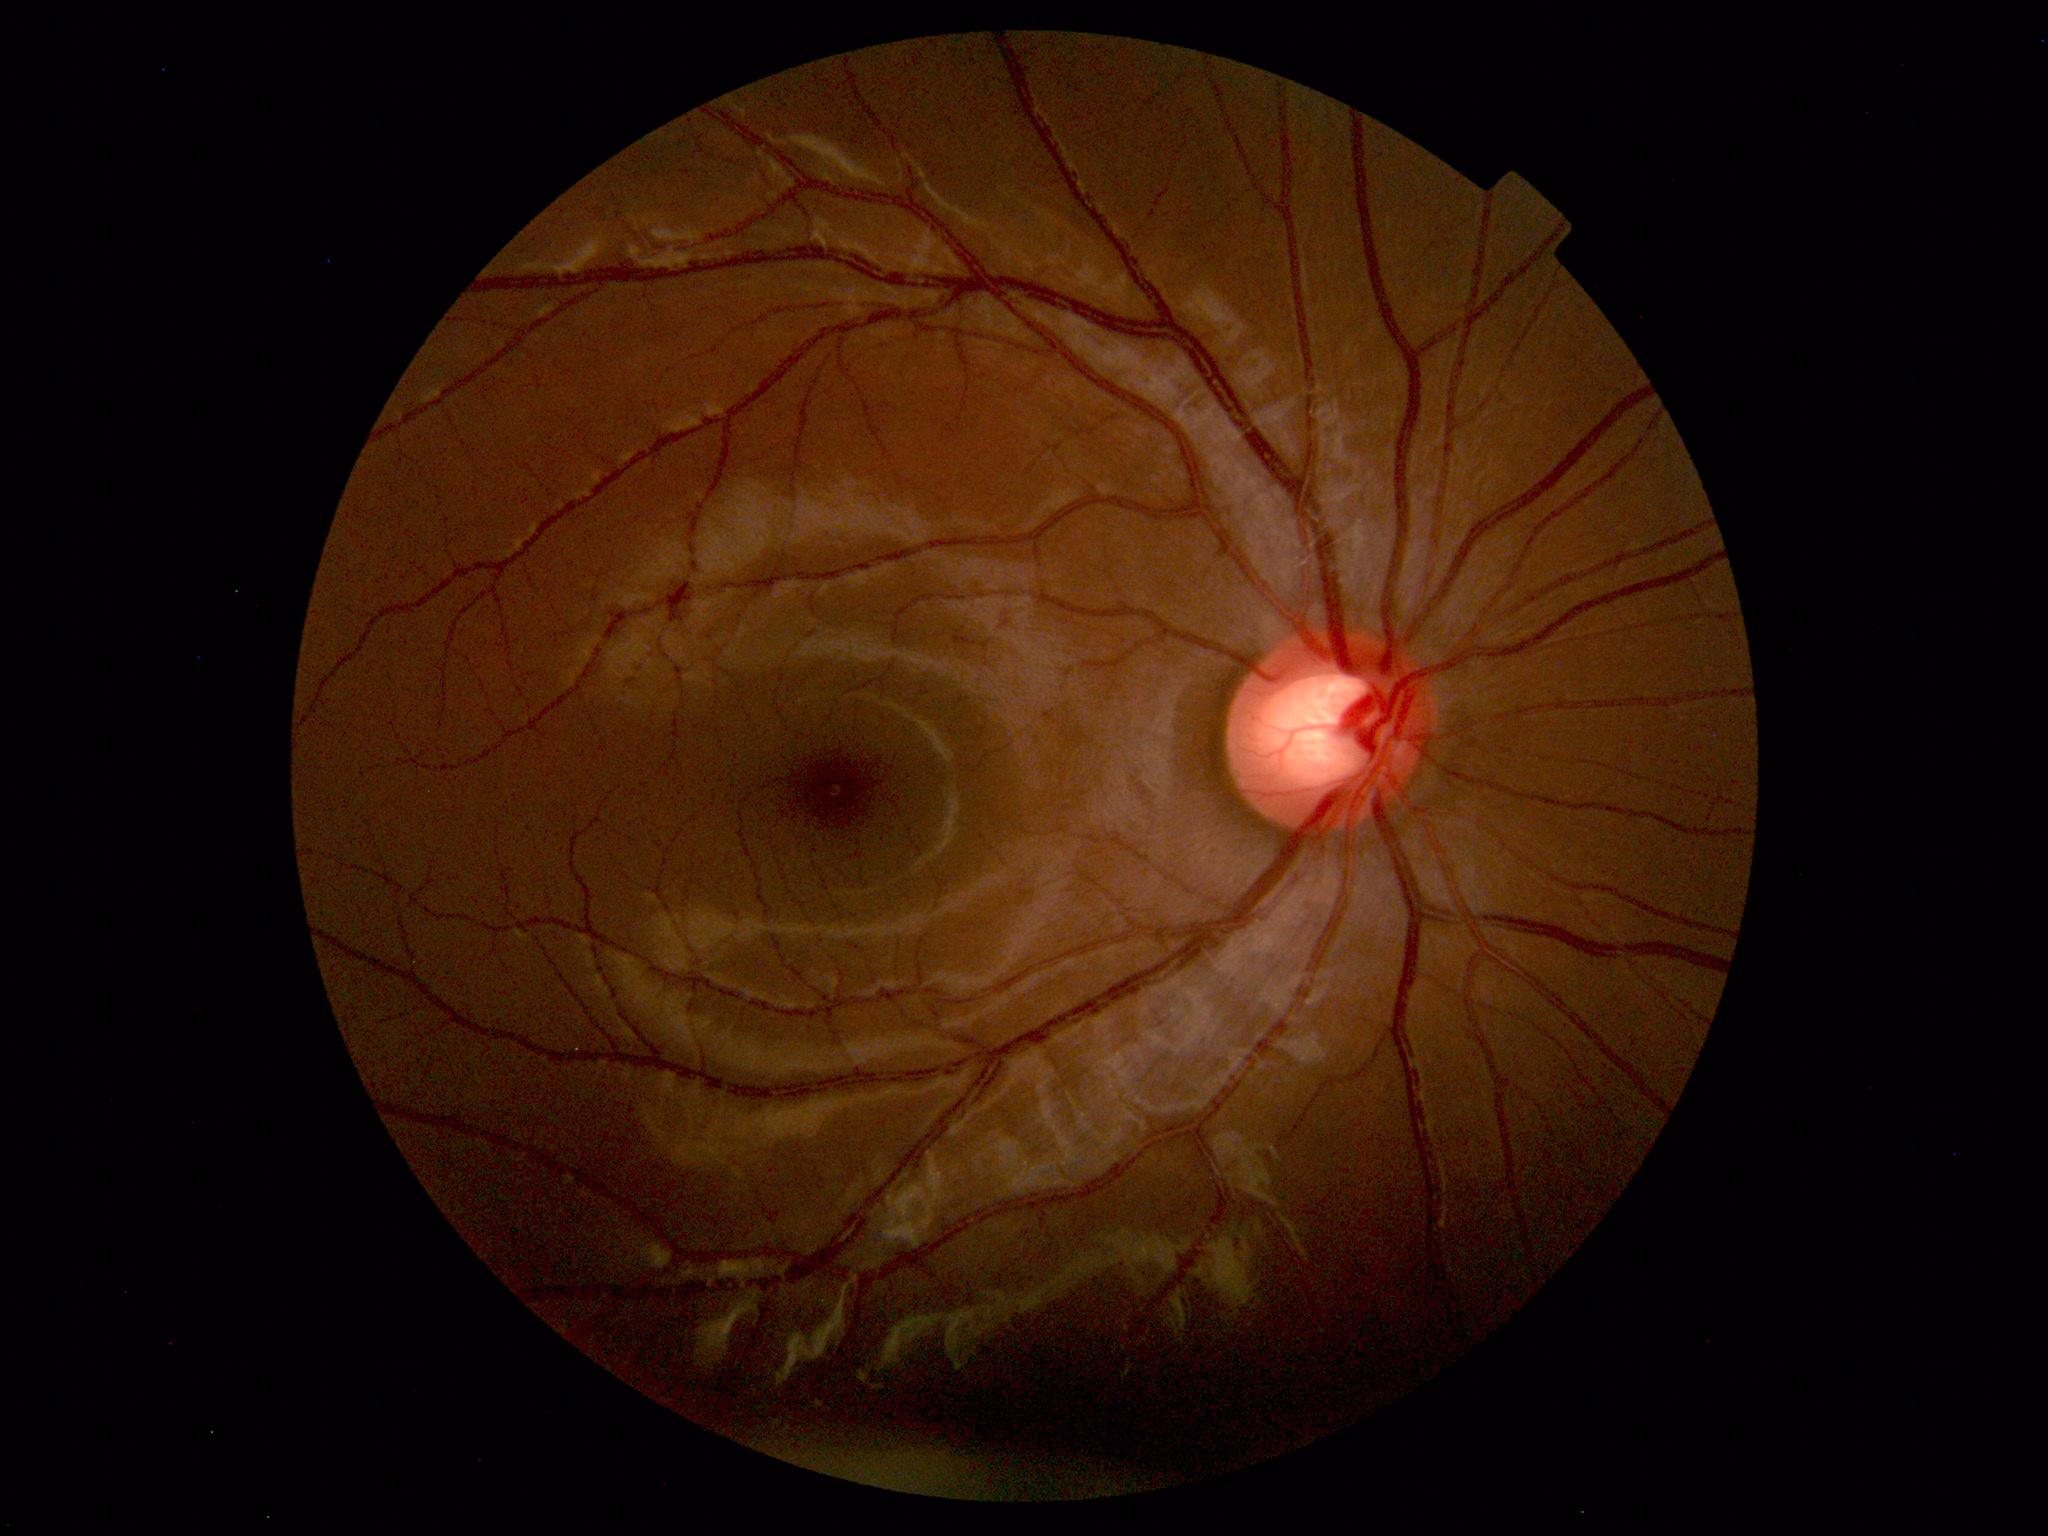 No retinal pathology identified.